50° FOV · Topcon TRC-50DX: 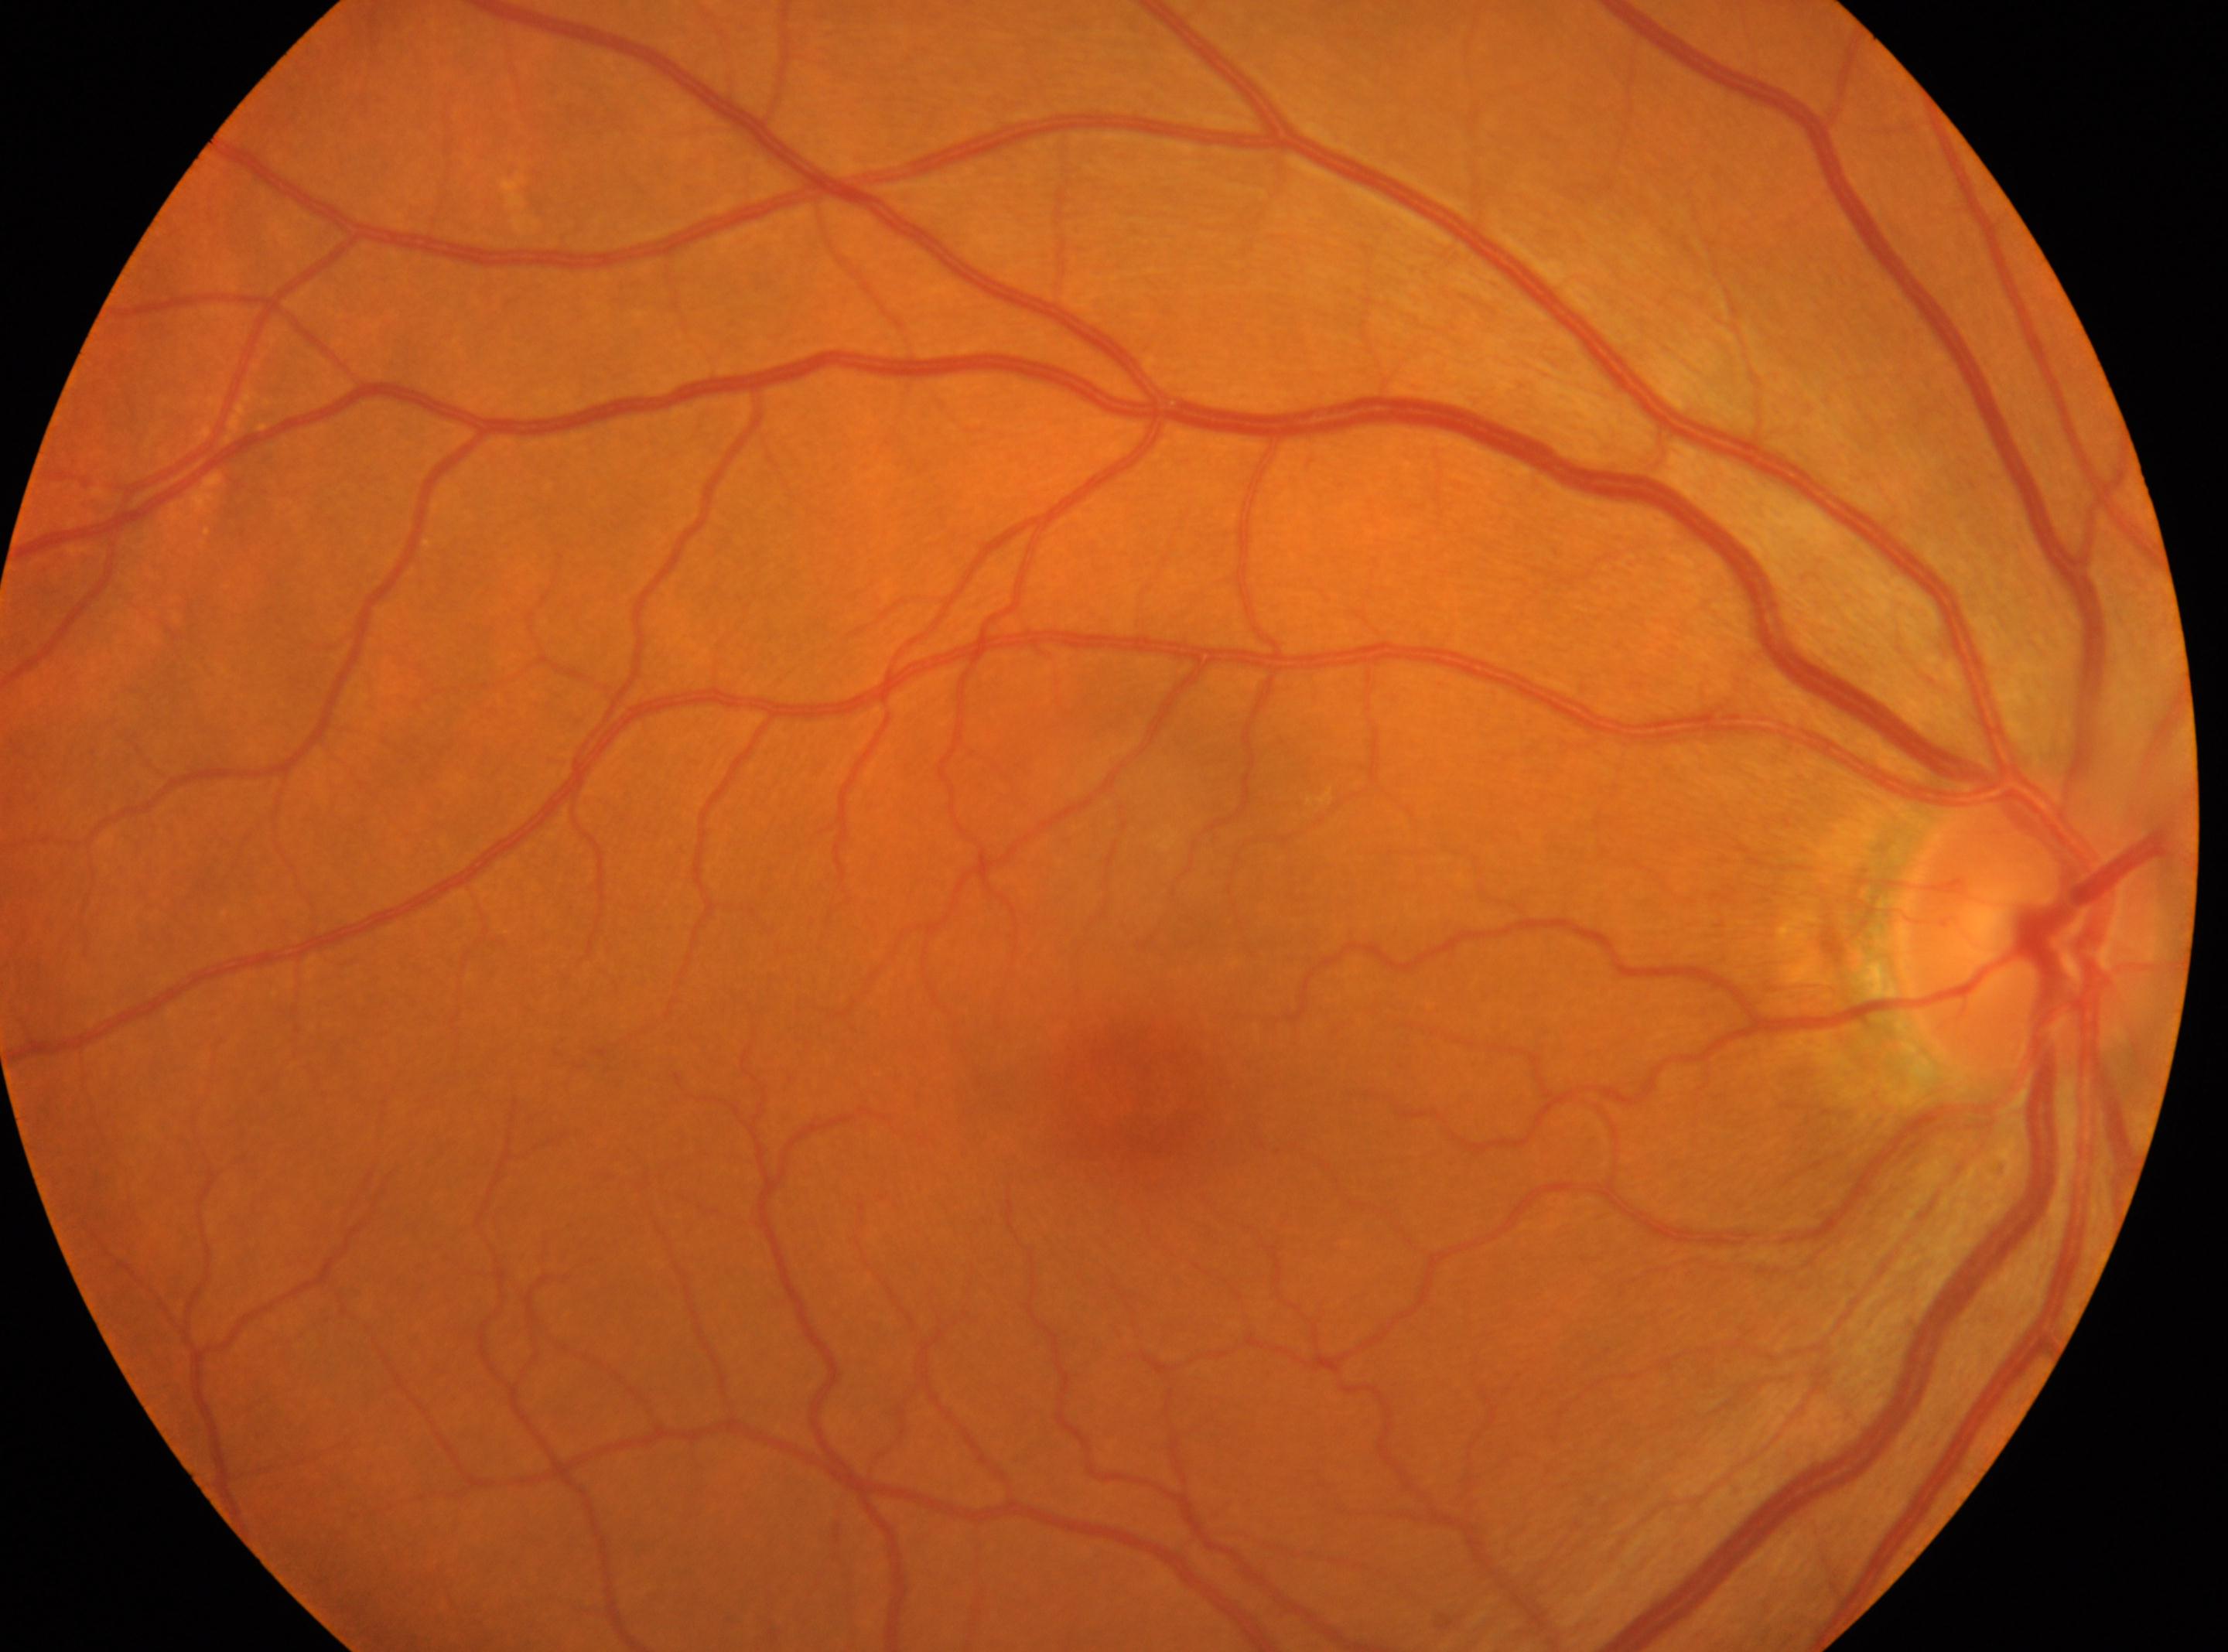

Imaged eye: the right eye. Retinopathy grade: 0 (no apparent retinopathy). The macula center is at [1146, 1091]. Optic disk: [2024, 927].